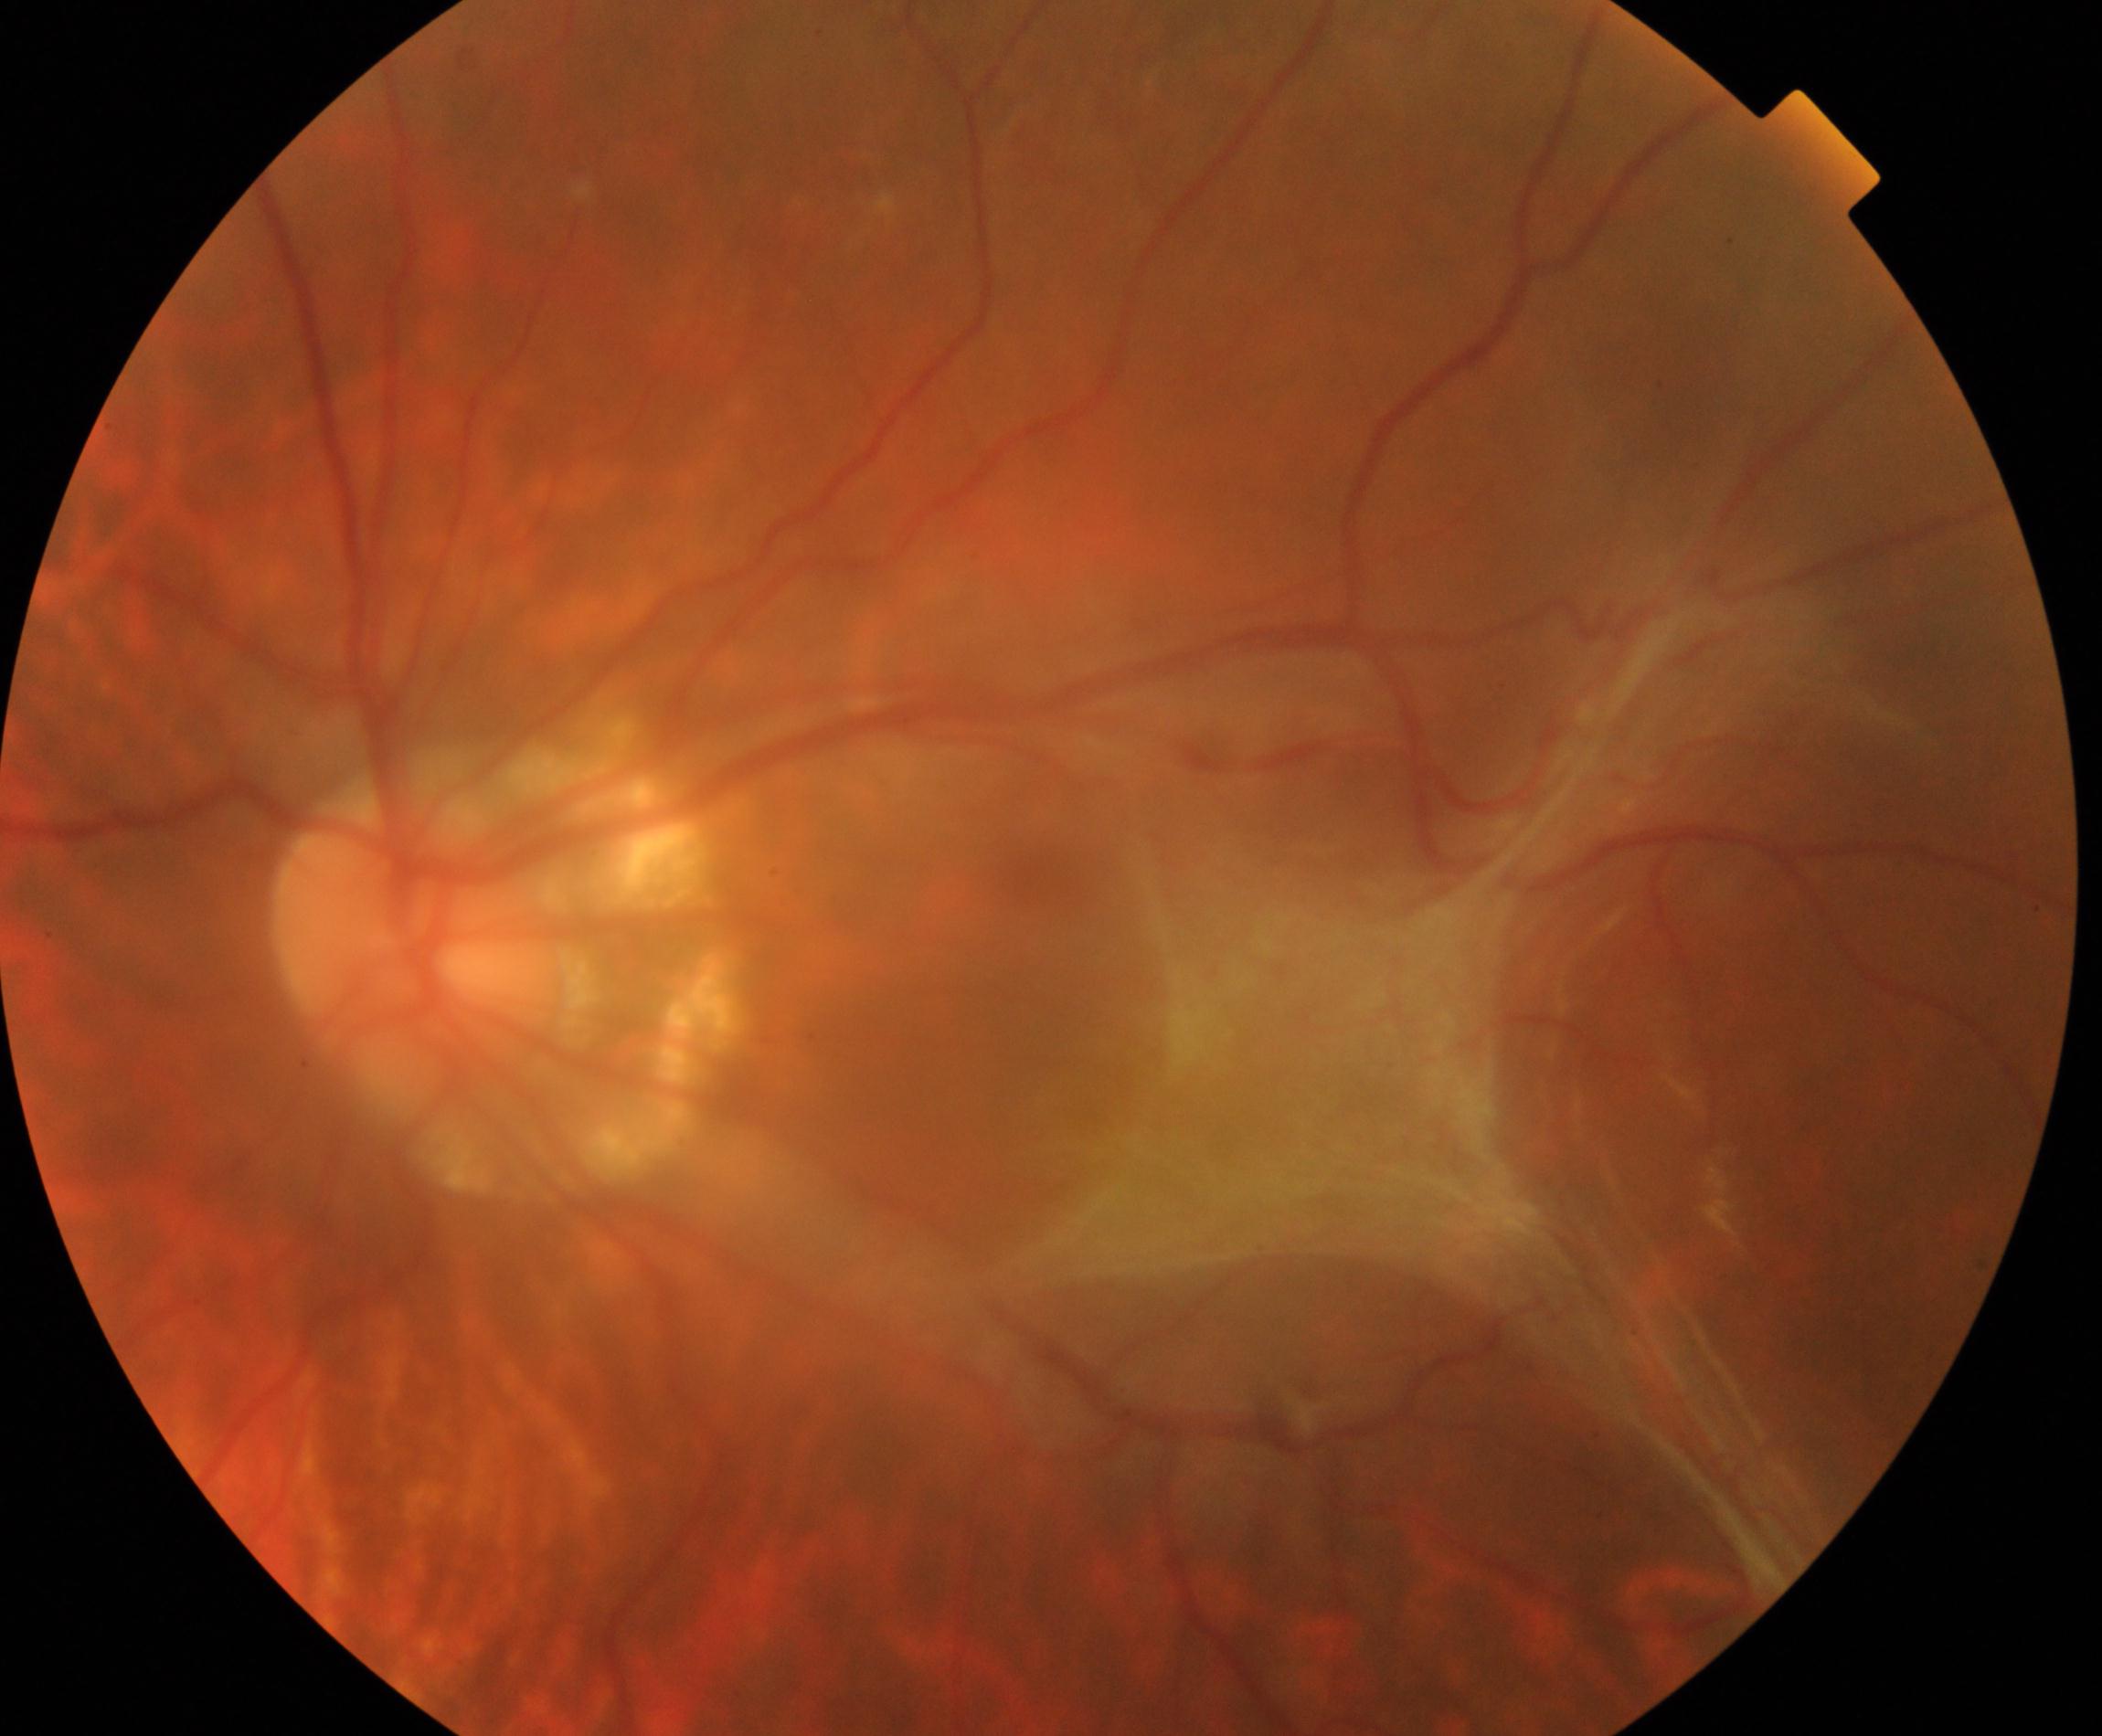

Demonstrates fibrosis.